2352 x 1568 pixels; color fundus image.
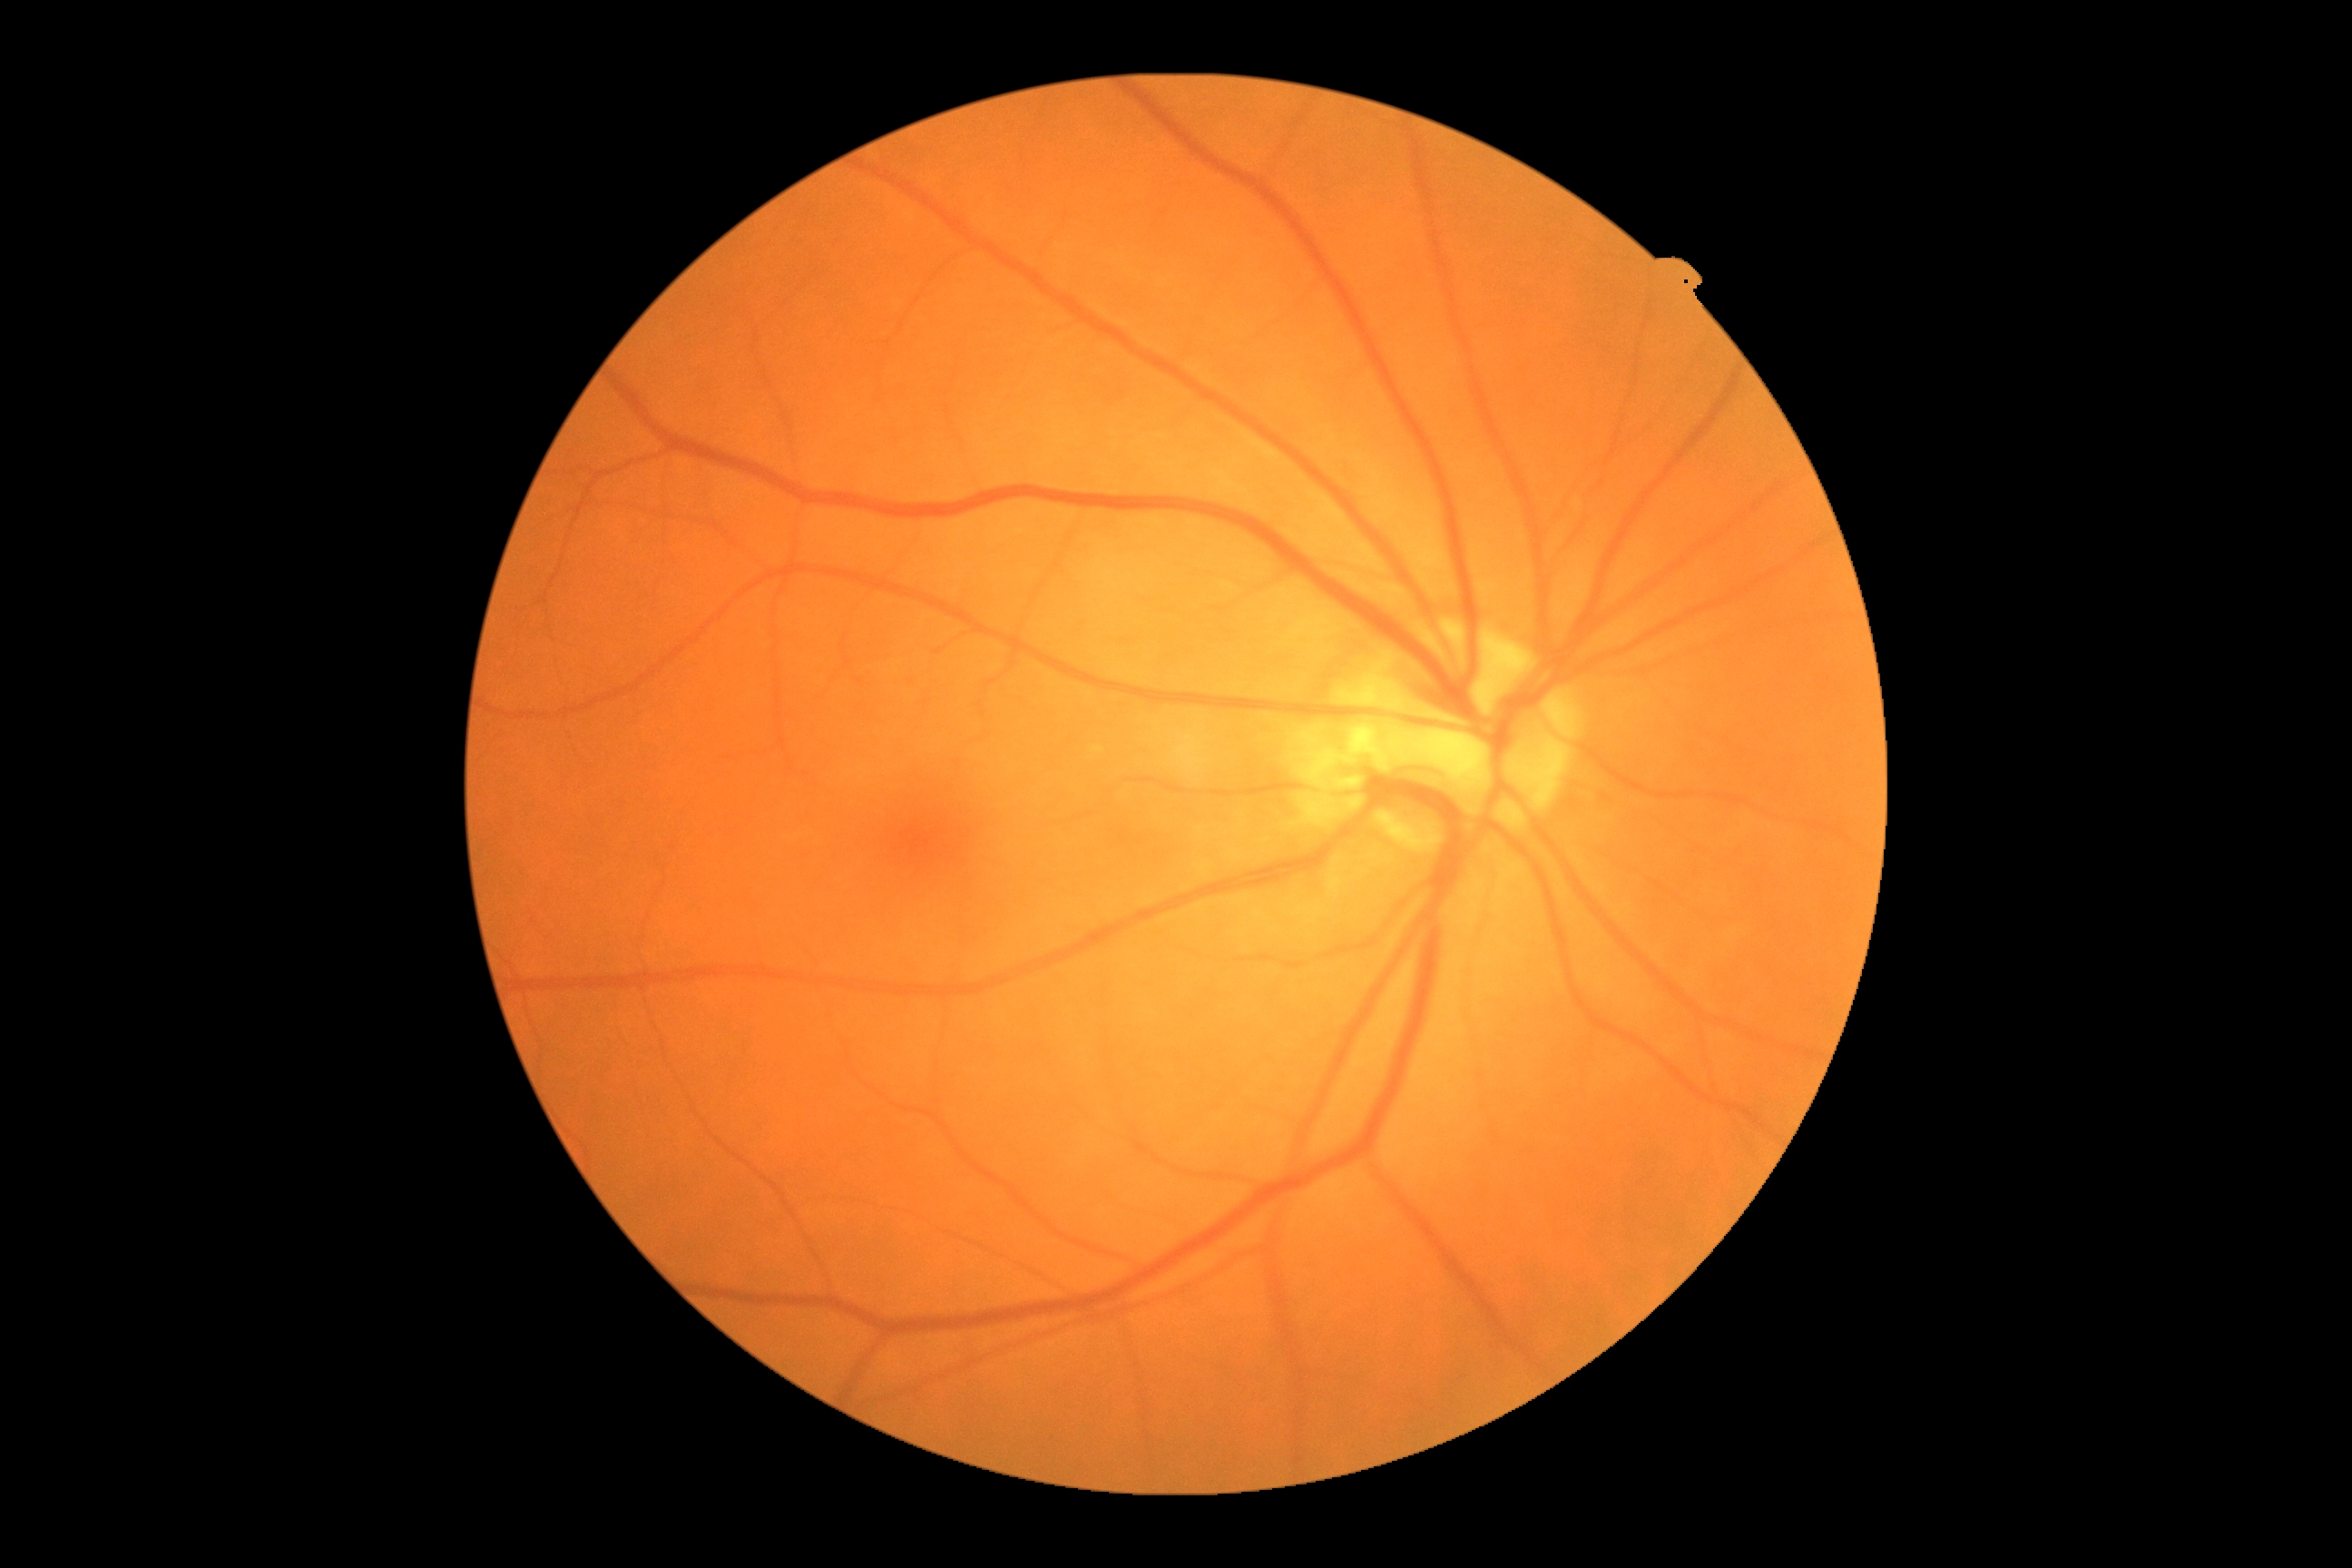
DR grade is no apparent diabetic retinopathy (0) — no visible signs of diabetic retinopathy.